Optic disc-centered crop from a color fundus photograph: 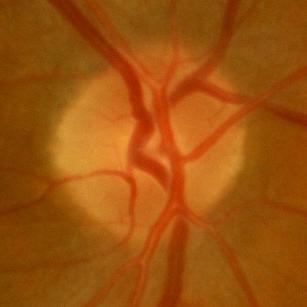
Q: Is glaucoma present?
A: No — no glaucomatous findings.